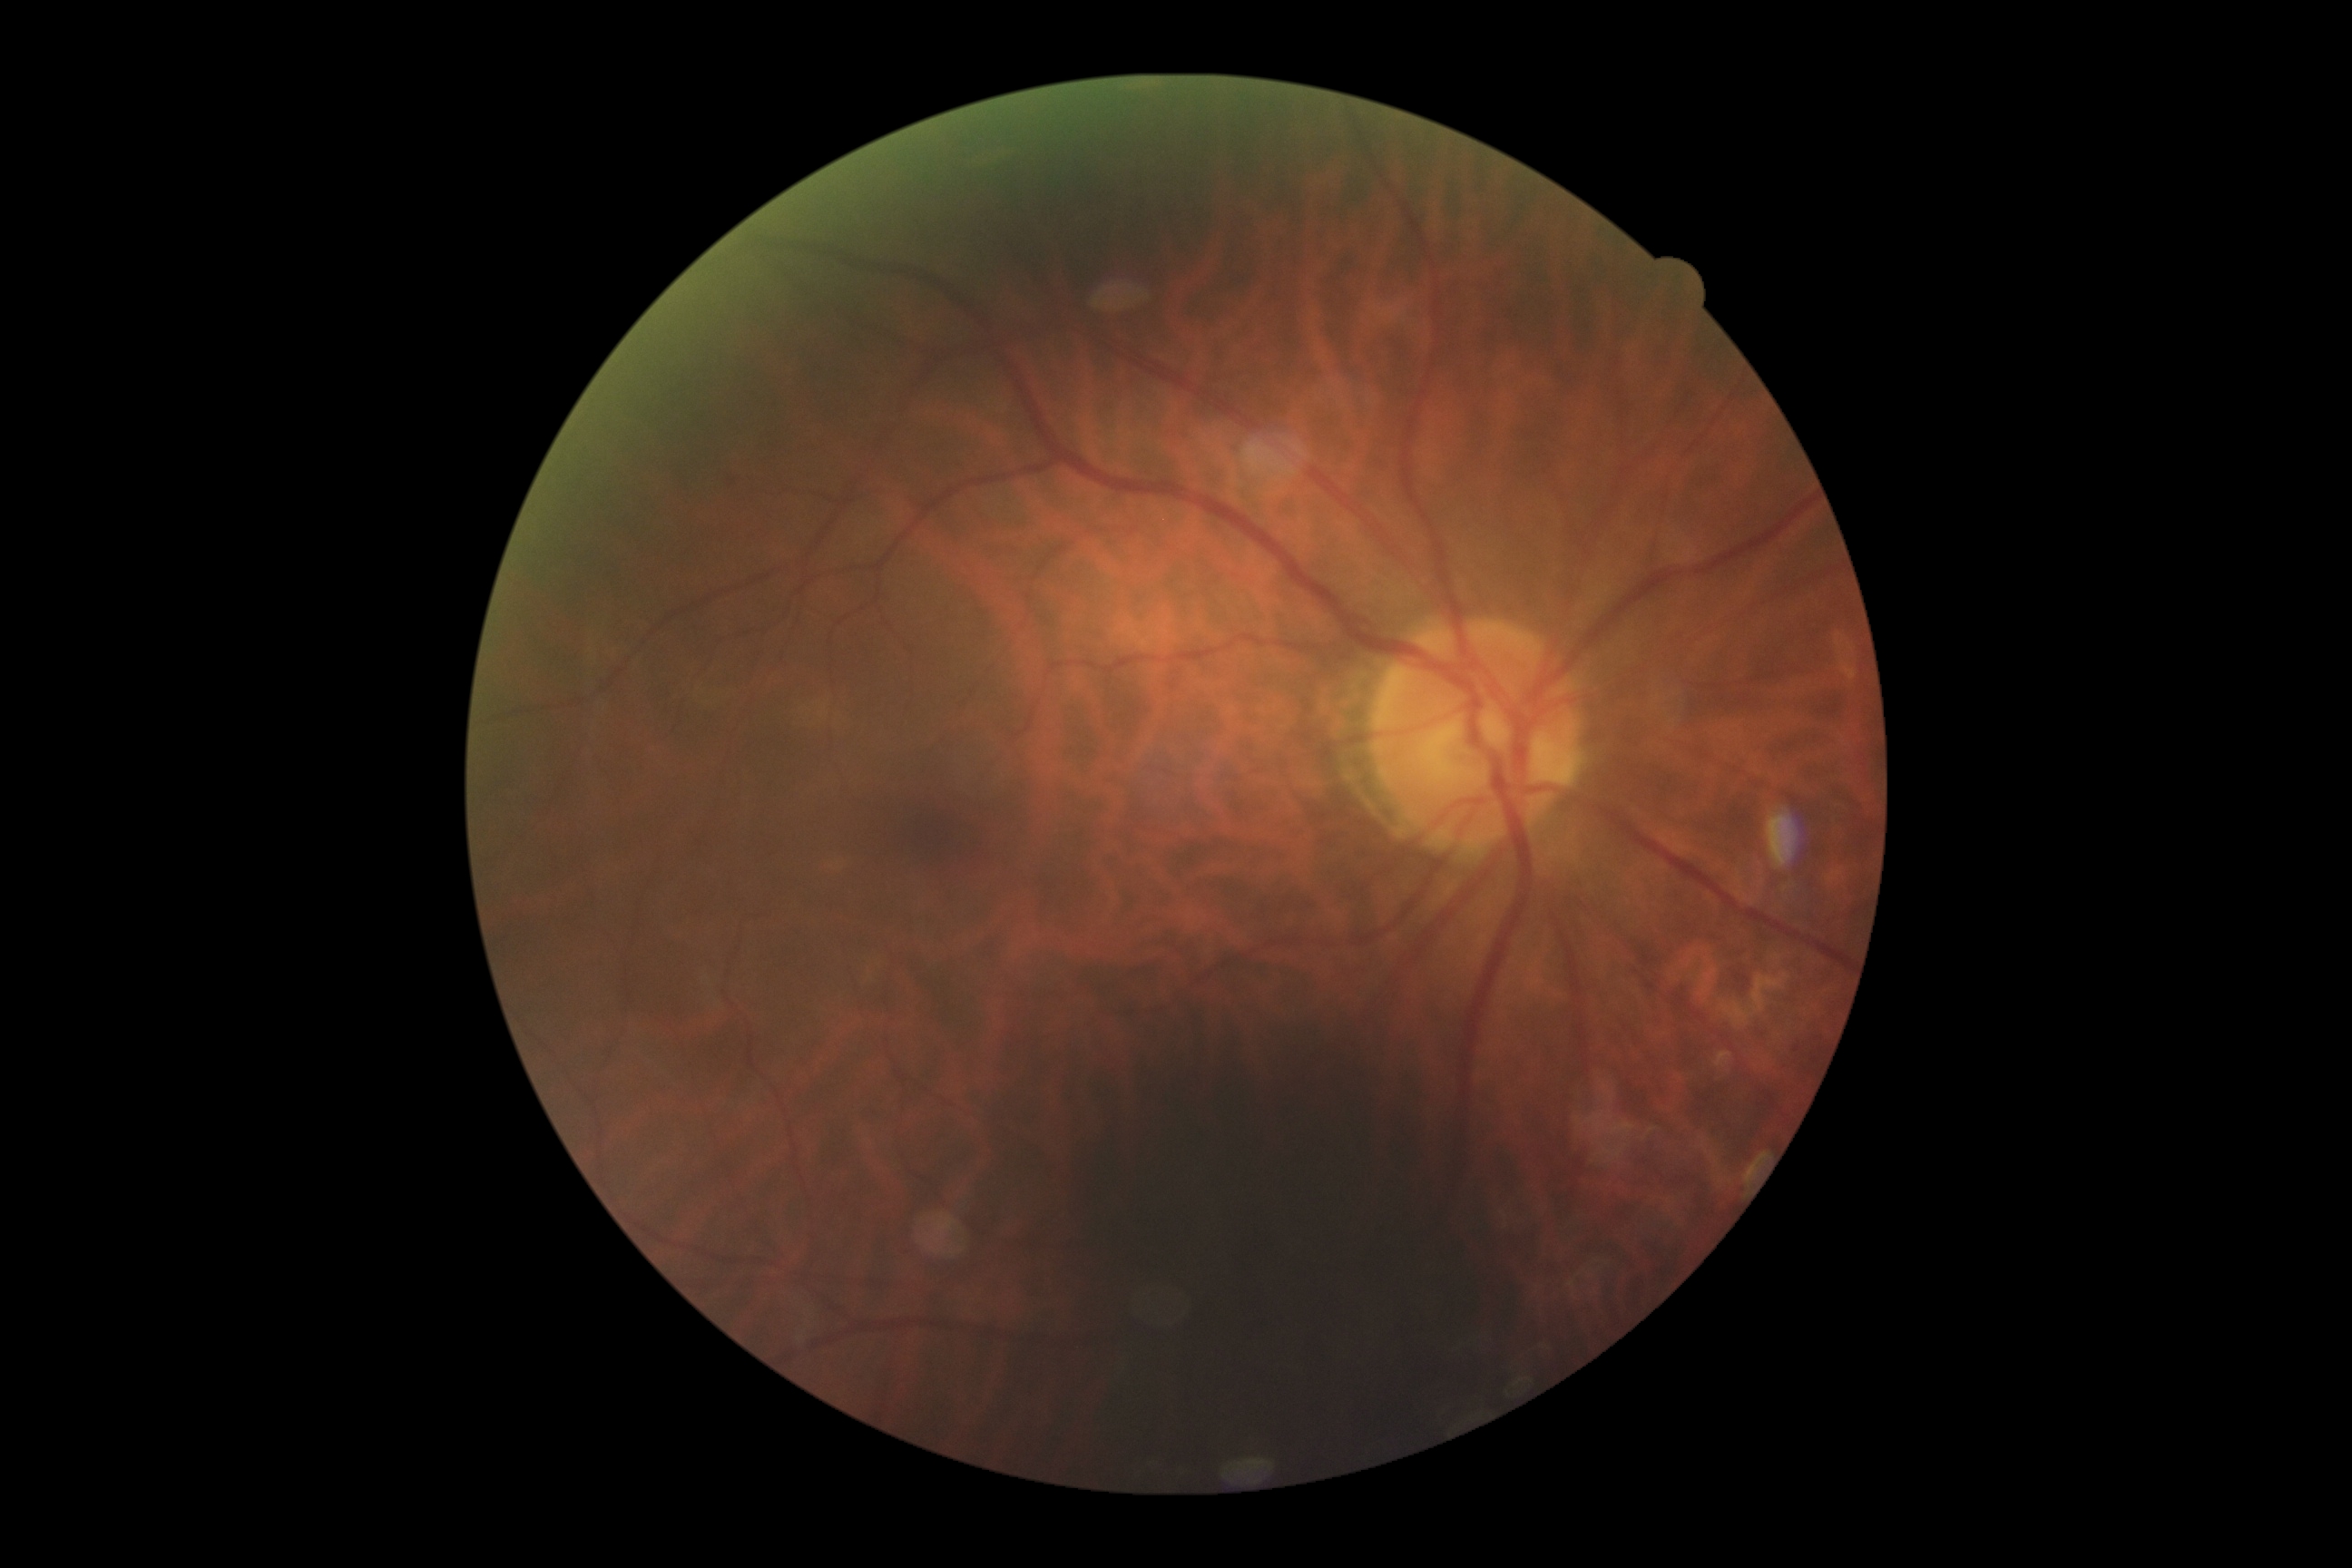
Retinopathy grade is 0/4.